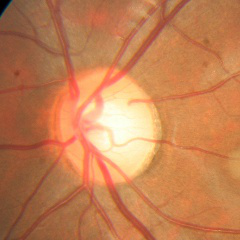
Q: Glaucoma assessment?
A: No — no evidence of glaucoma.